848x848; acquired with a NIDEK AFC-230; posterior pole color fundus photograph.
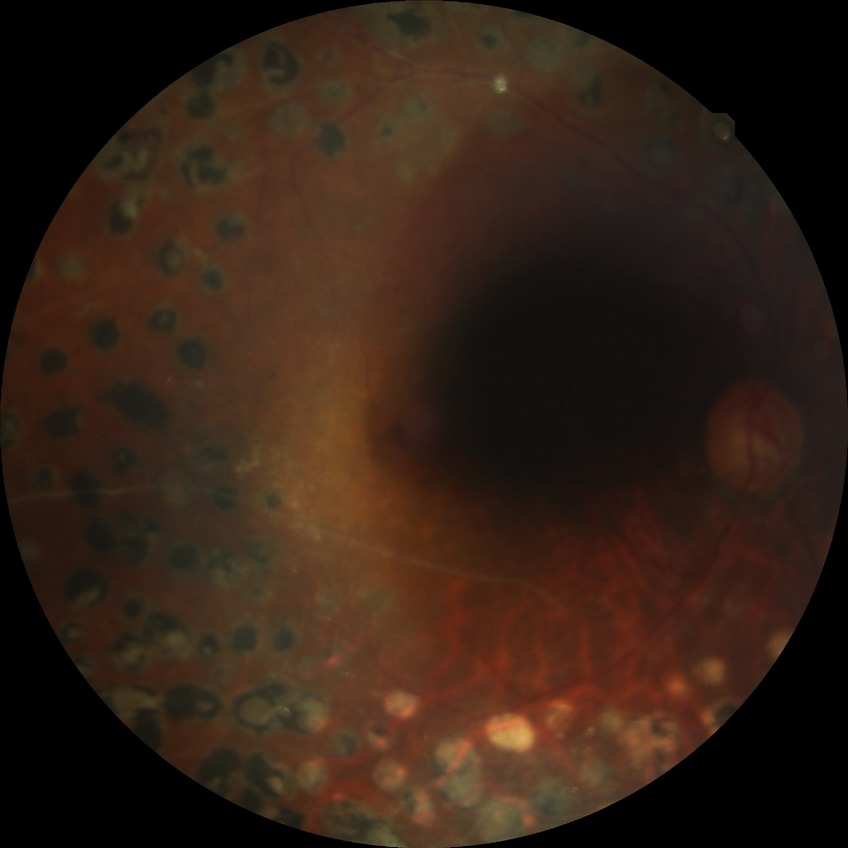 Davis grading: proliferative diabetic retinopathy.